Wide-field contact fundus photograph of an infant; 1240 x 1240 pixels; acquired on the Phoenix ICON:
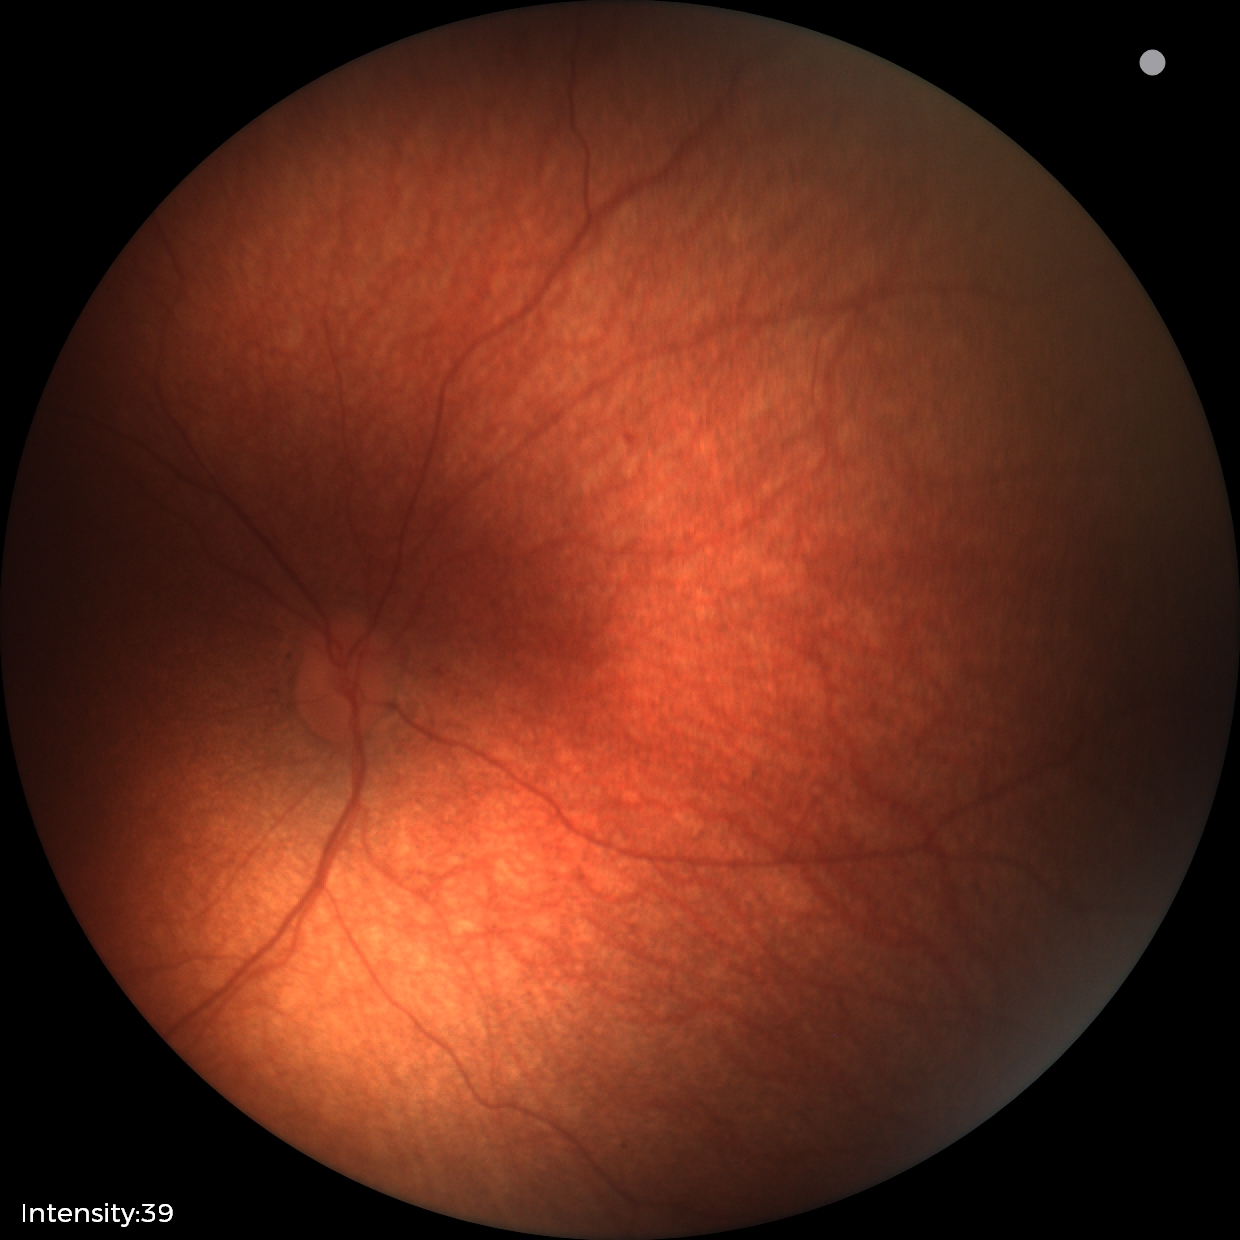
Normal screening examination.